Disc-centered field.
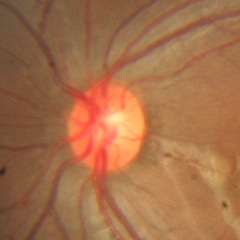
No glaucoma.